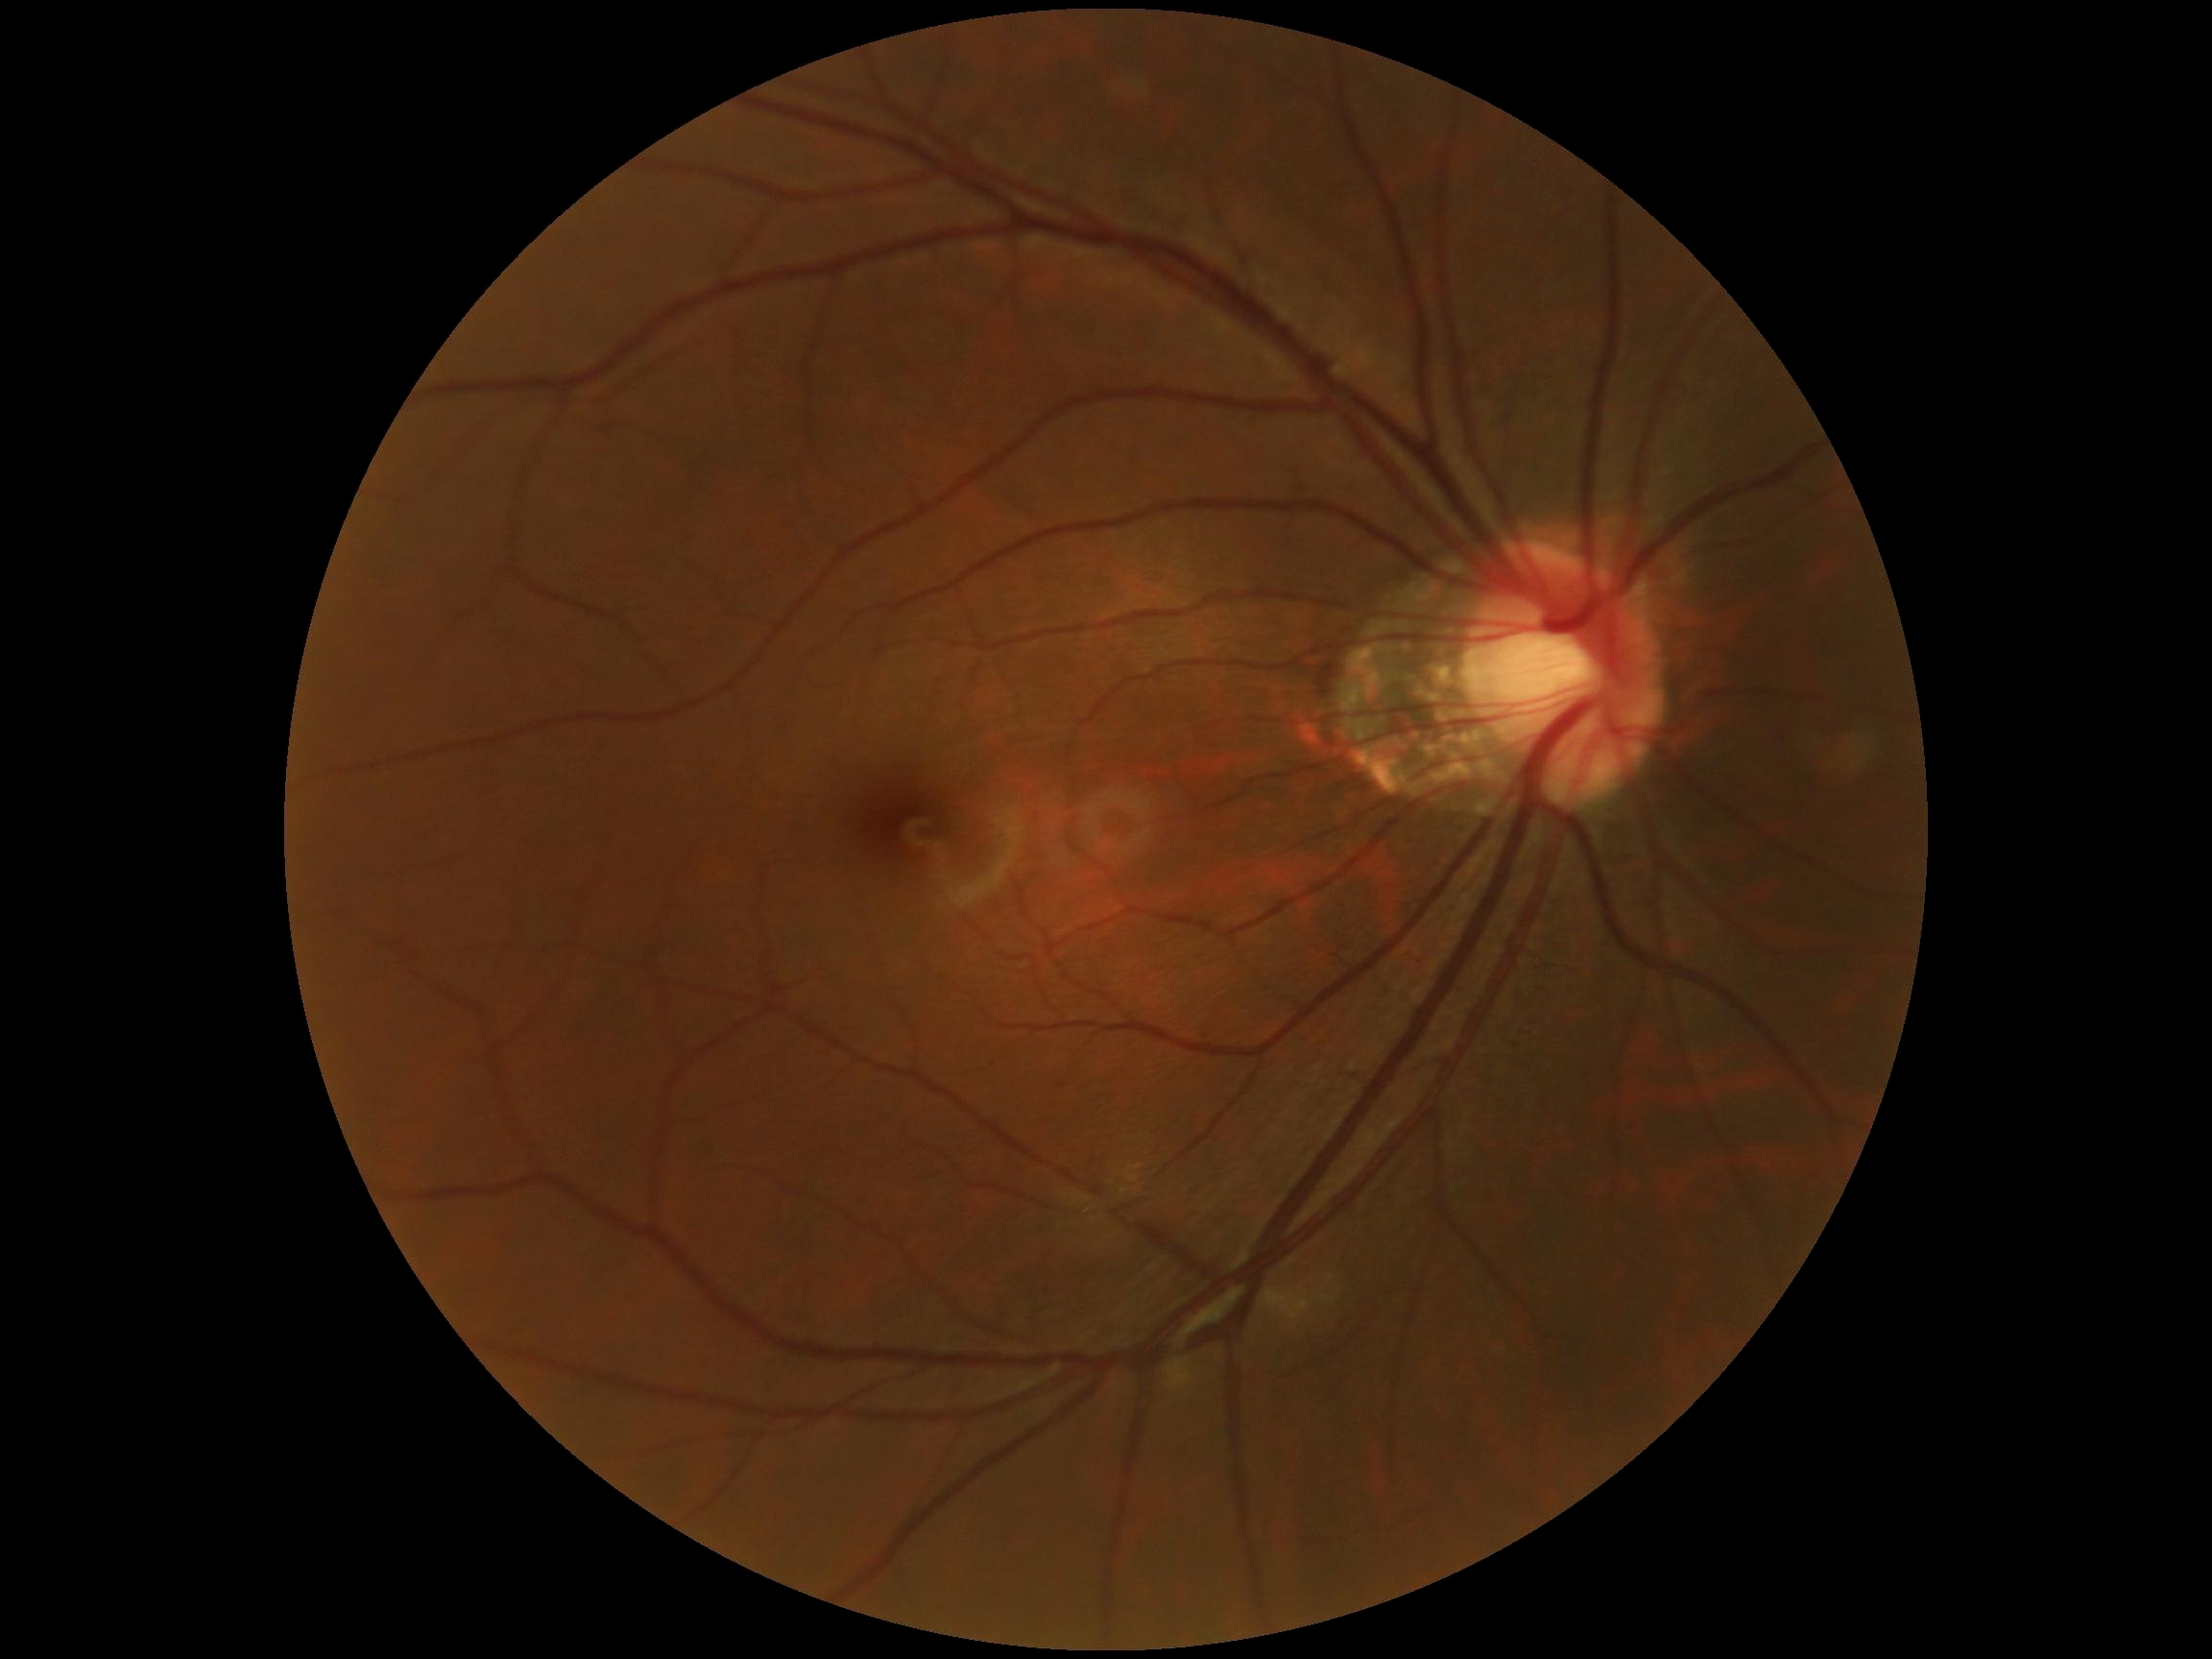

DR impression: no apparent DR
retinopathy grade: 0 (no apparent retinopathy) — no visible signs of diabetic retinopathy